Mydriatic (tropicamide and phenylephrine):
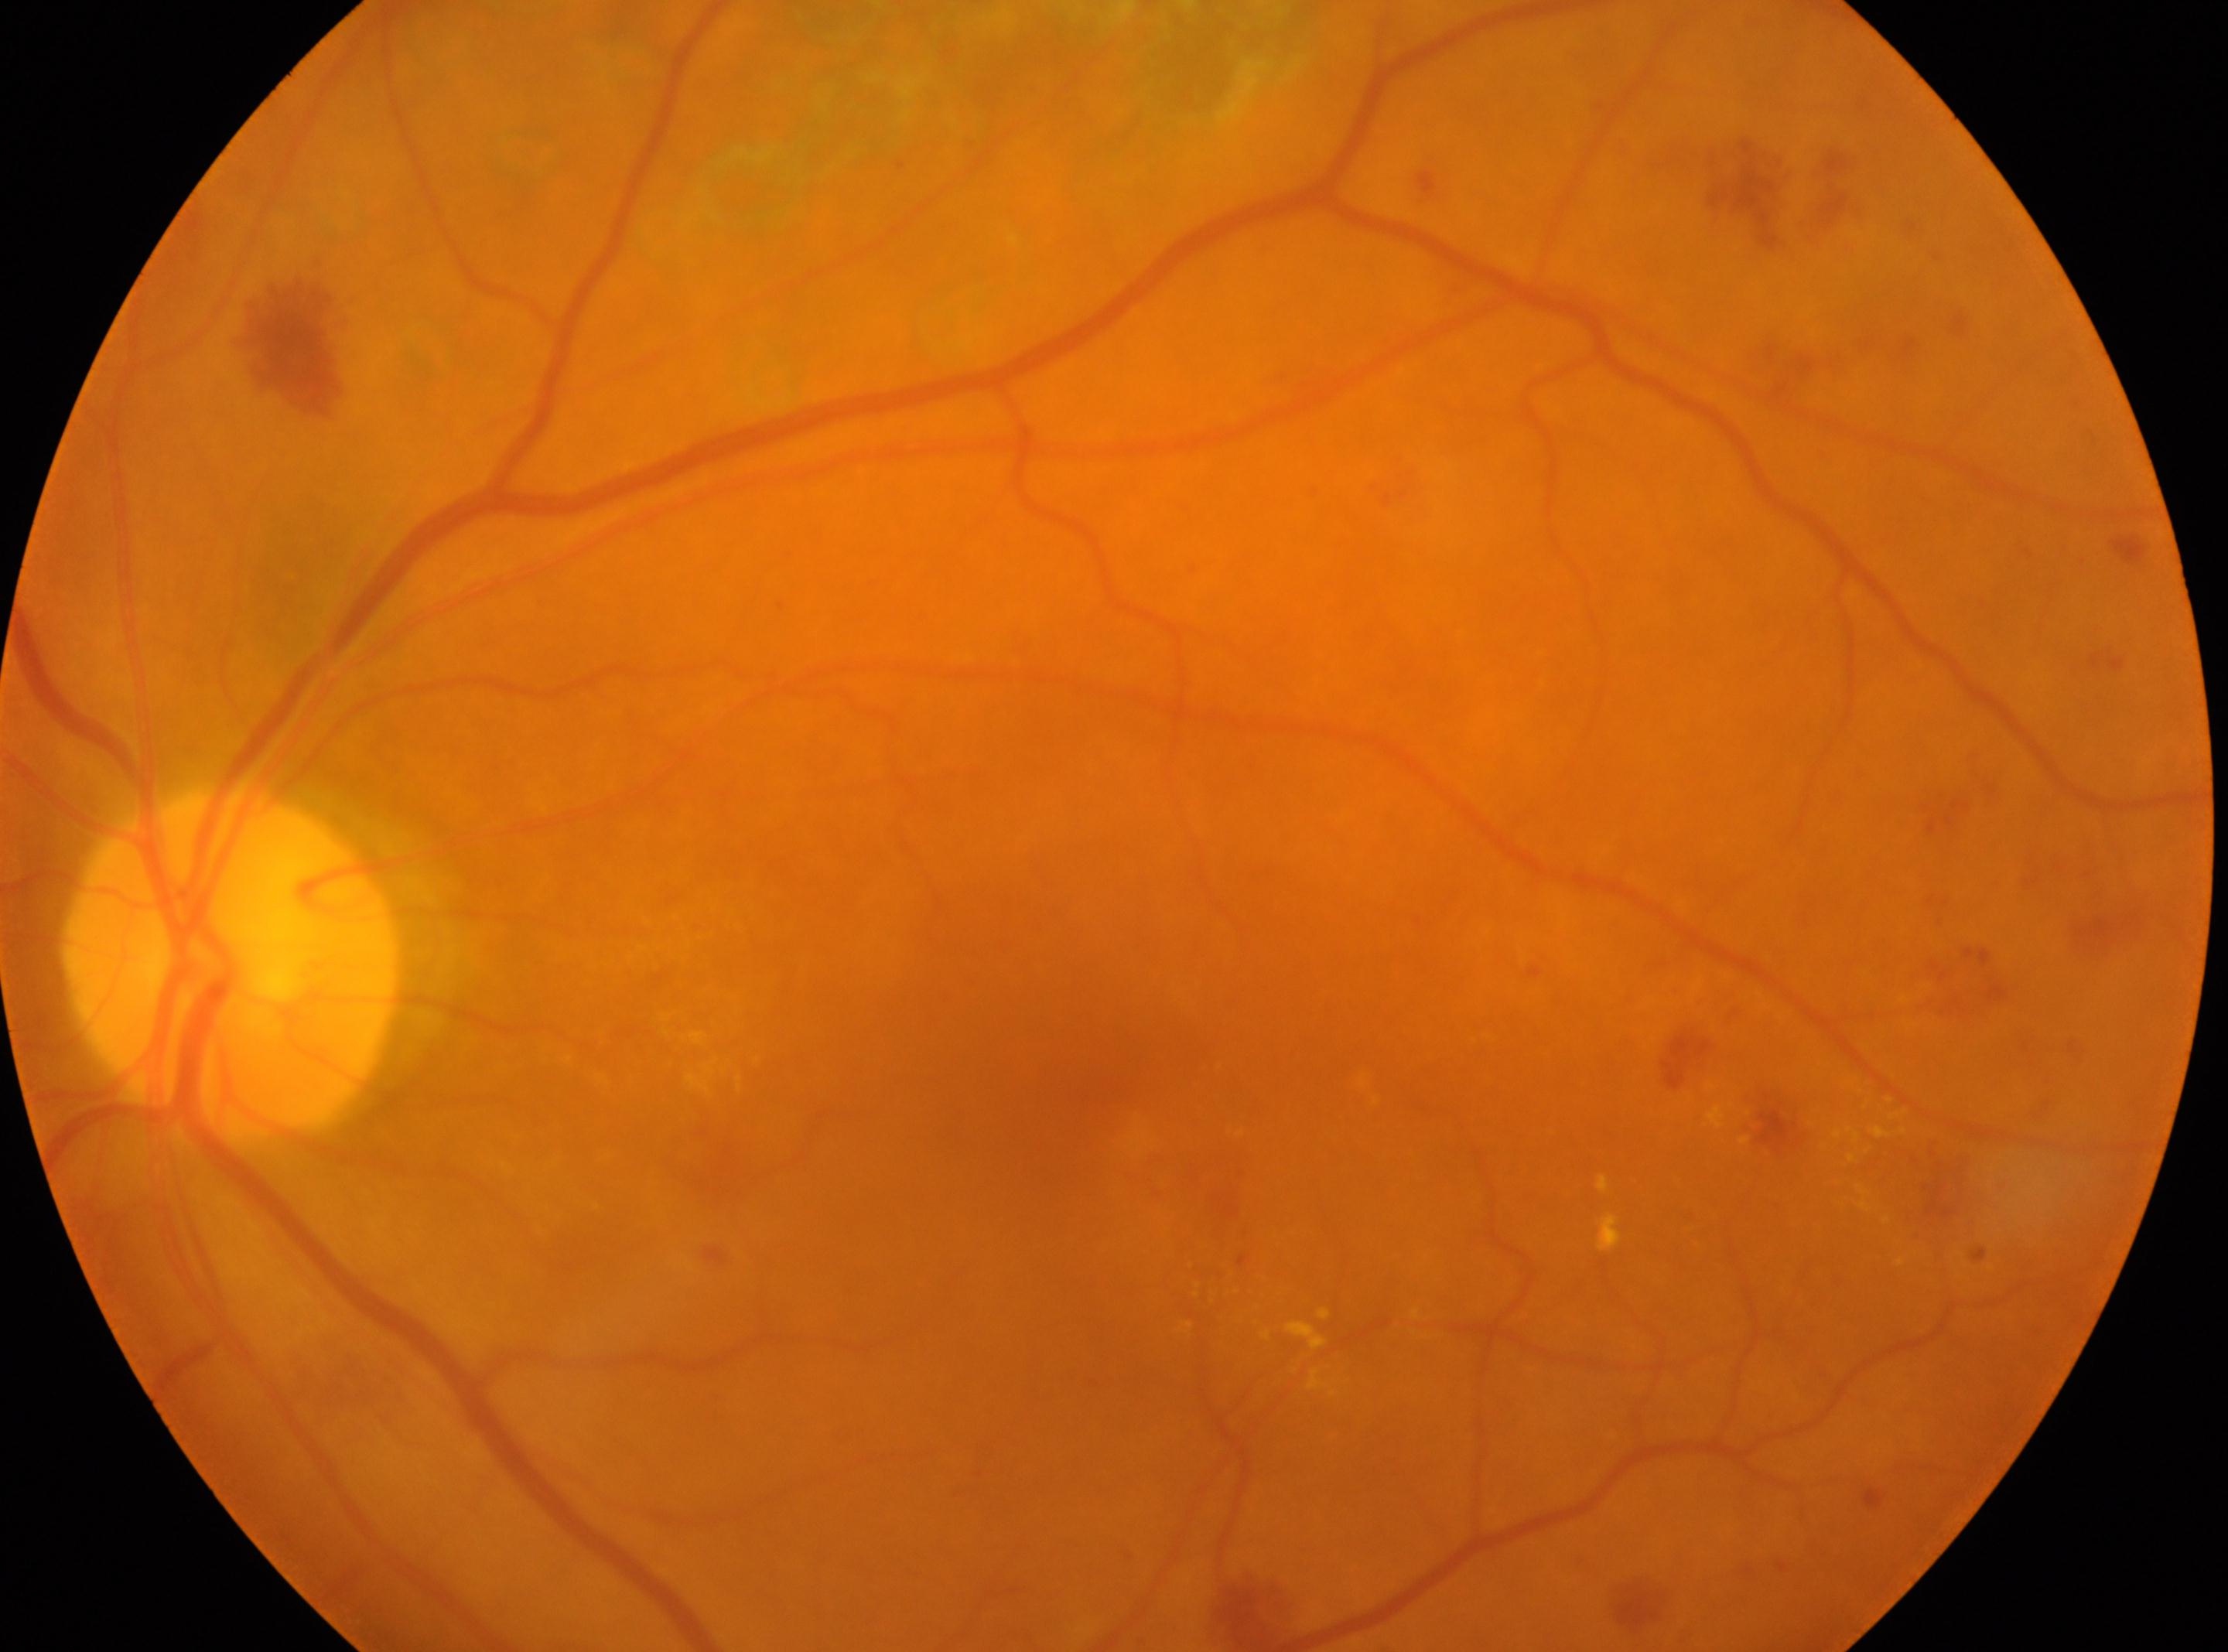
Imaged eye: left eye. Optic disc: (x=229, y=964). DR grade is post-photocoagulation DR, underlying severity grade 2 (moderate NPDR). Foveal center located at (x=1051, y=1101).